RetCam wide-field infant fundus image. 640x480 — 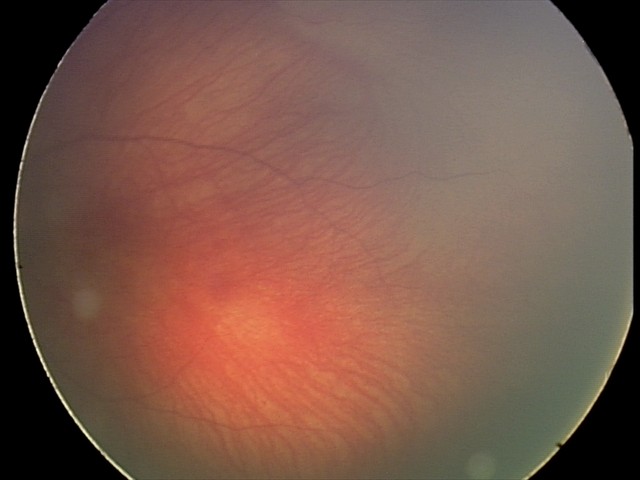

Examination diagnosed as retinal hemorrhages.